Fundus photo — 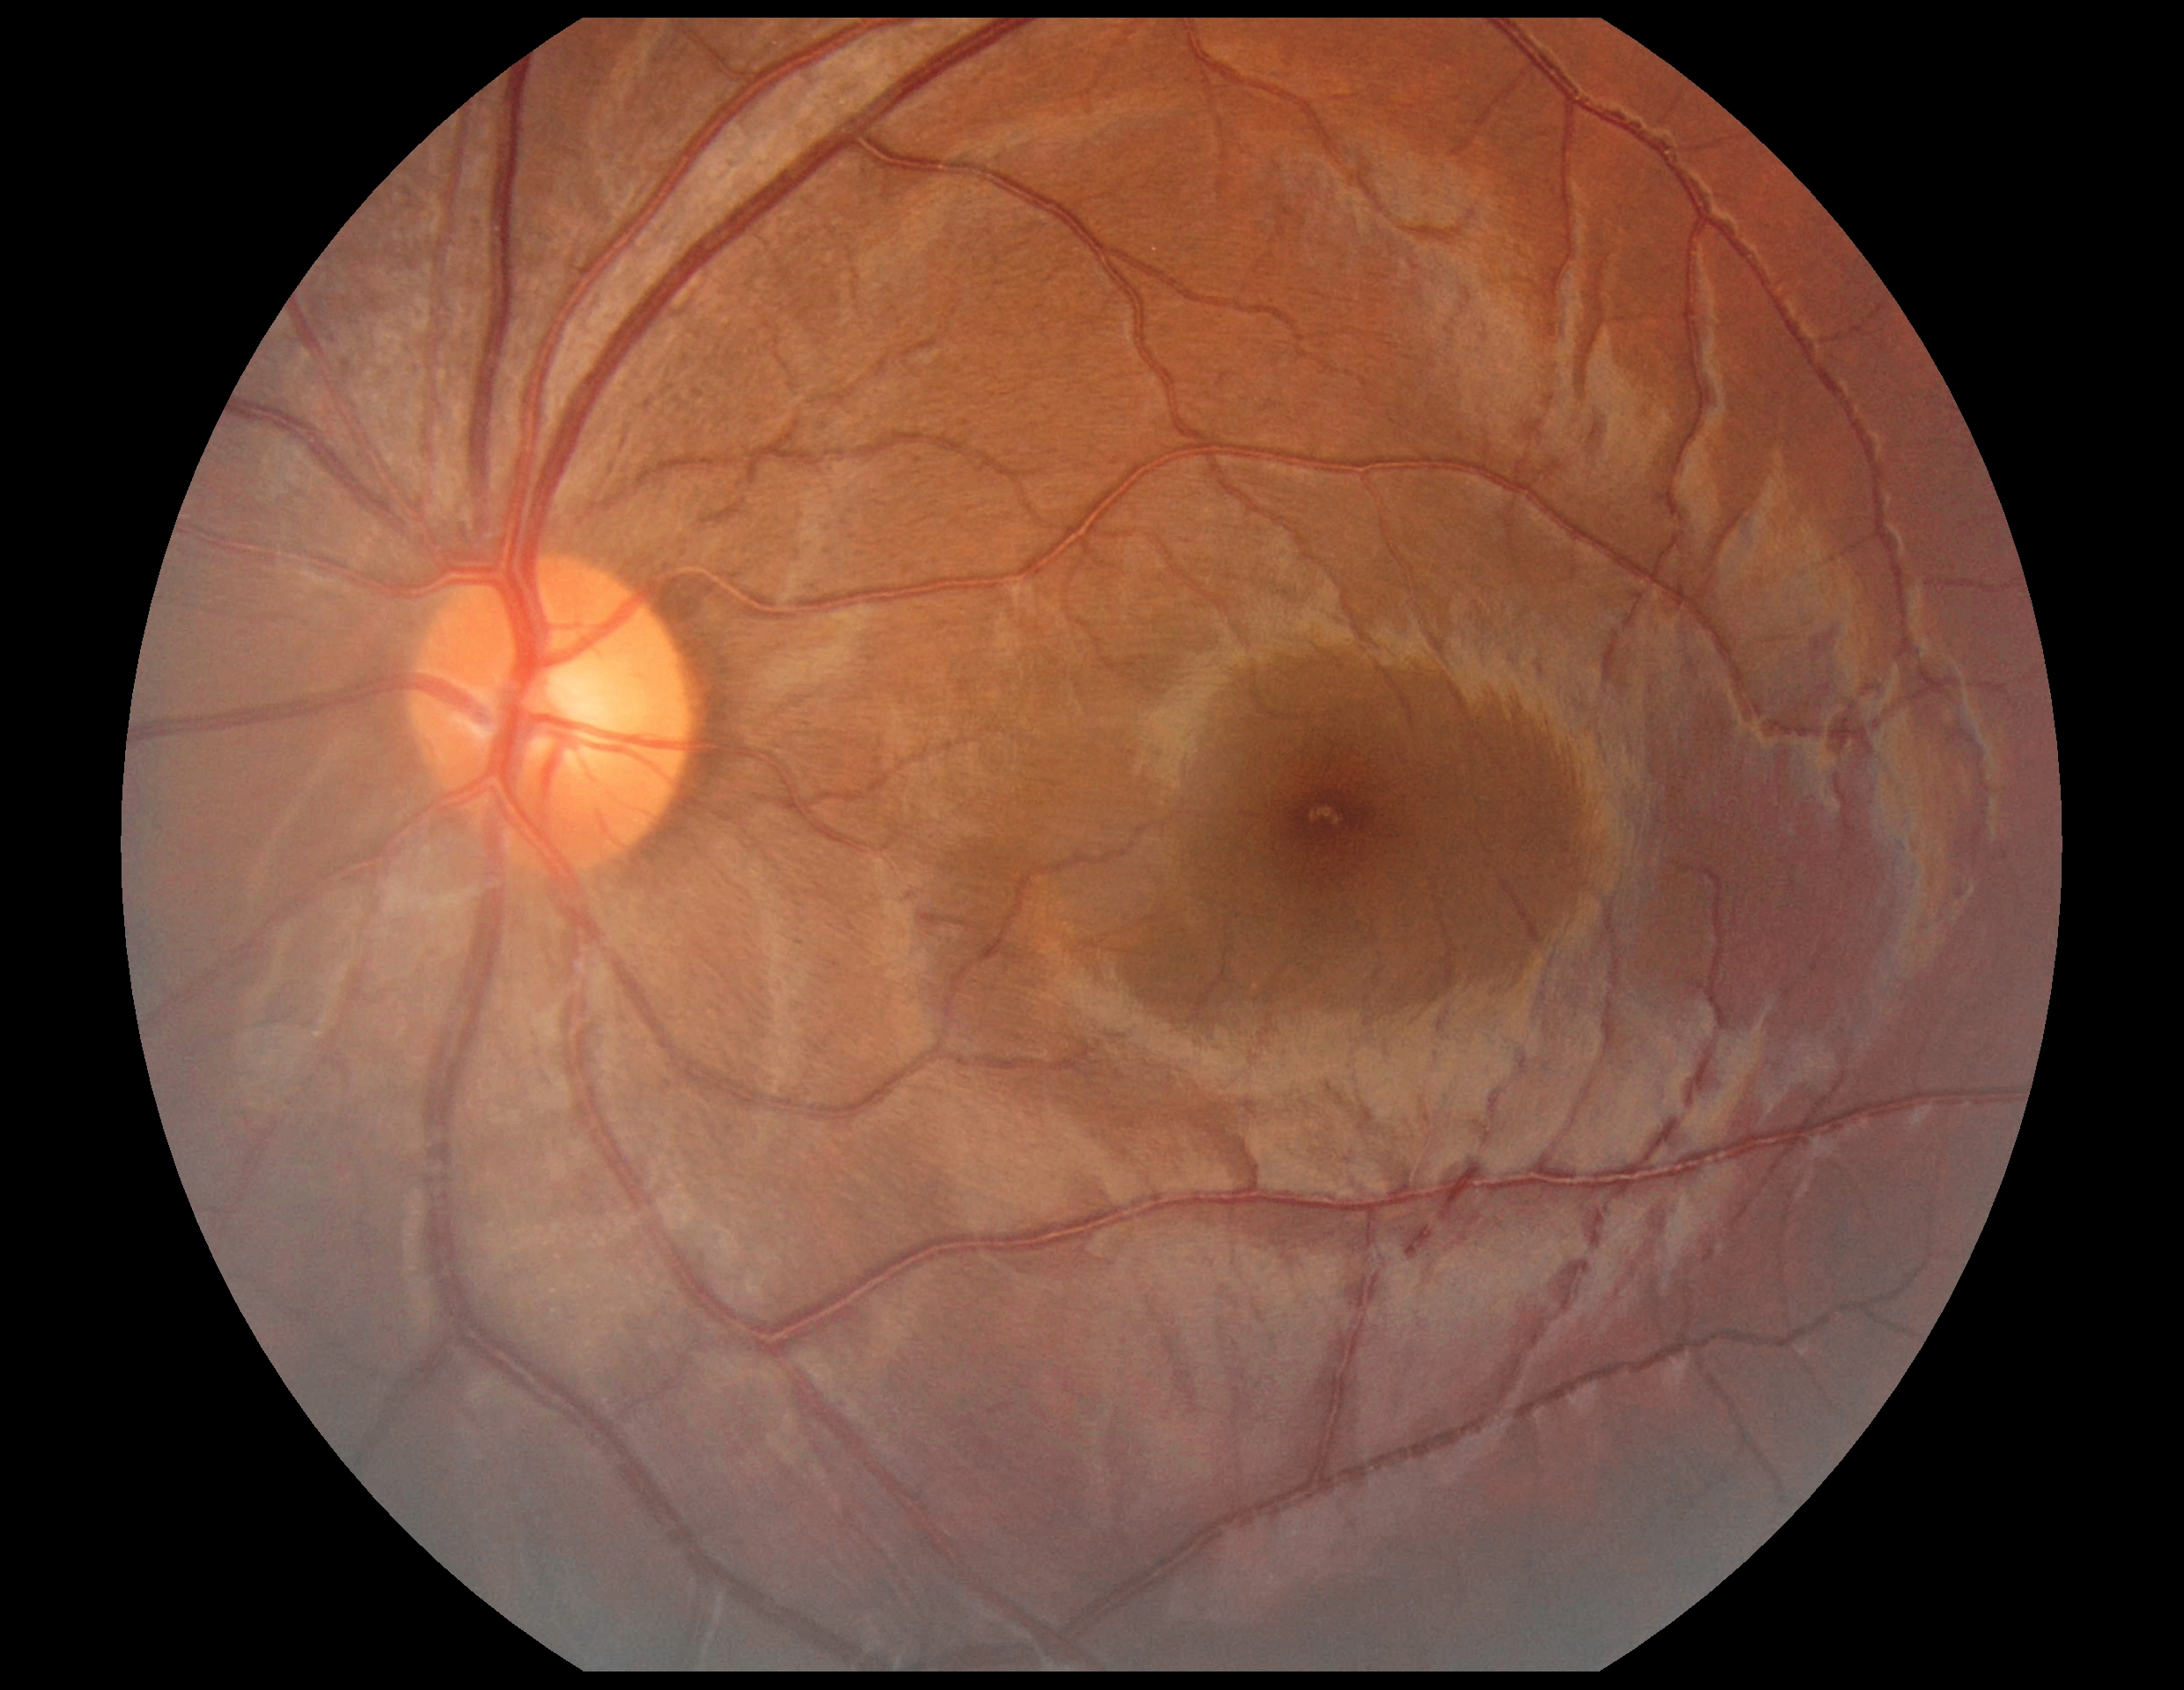 DR grade: 0 (no apparent retinopathy). No apparent diabetic retinopathy.